640x480px; RetCam wide-field infant fundus image; 130° field of view (Clarity RetCam 3): 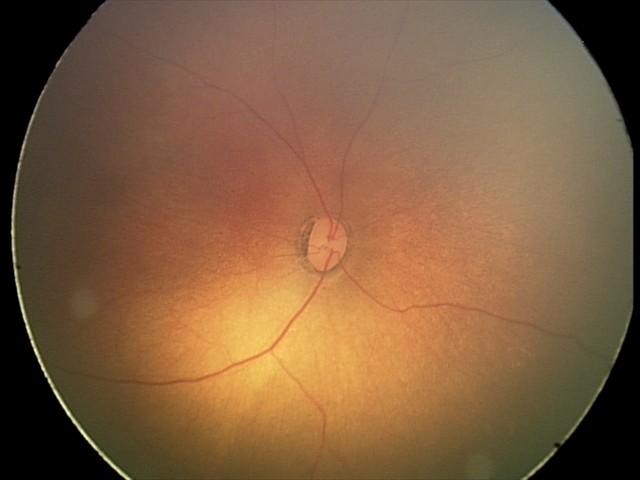
Q: What is the diagnosis from this examination?
A: no abnormal retinal findings